Pediatric wide-field fundus photograph; 1240x1240; camera: Phoenix ICON (100° FOV) — 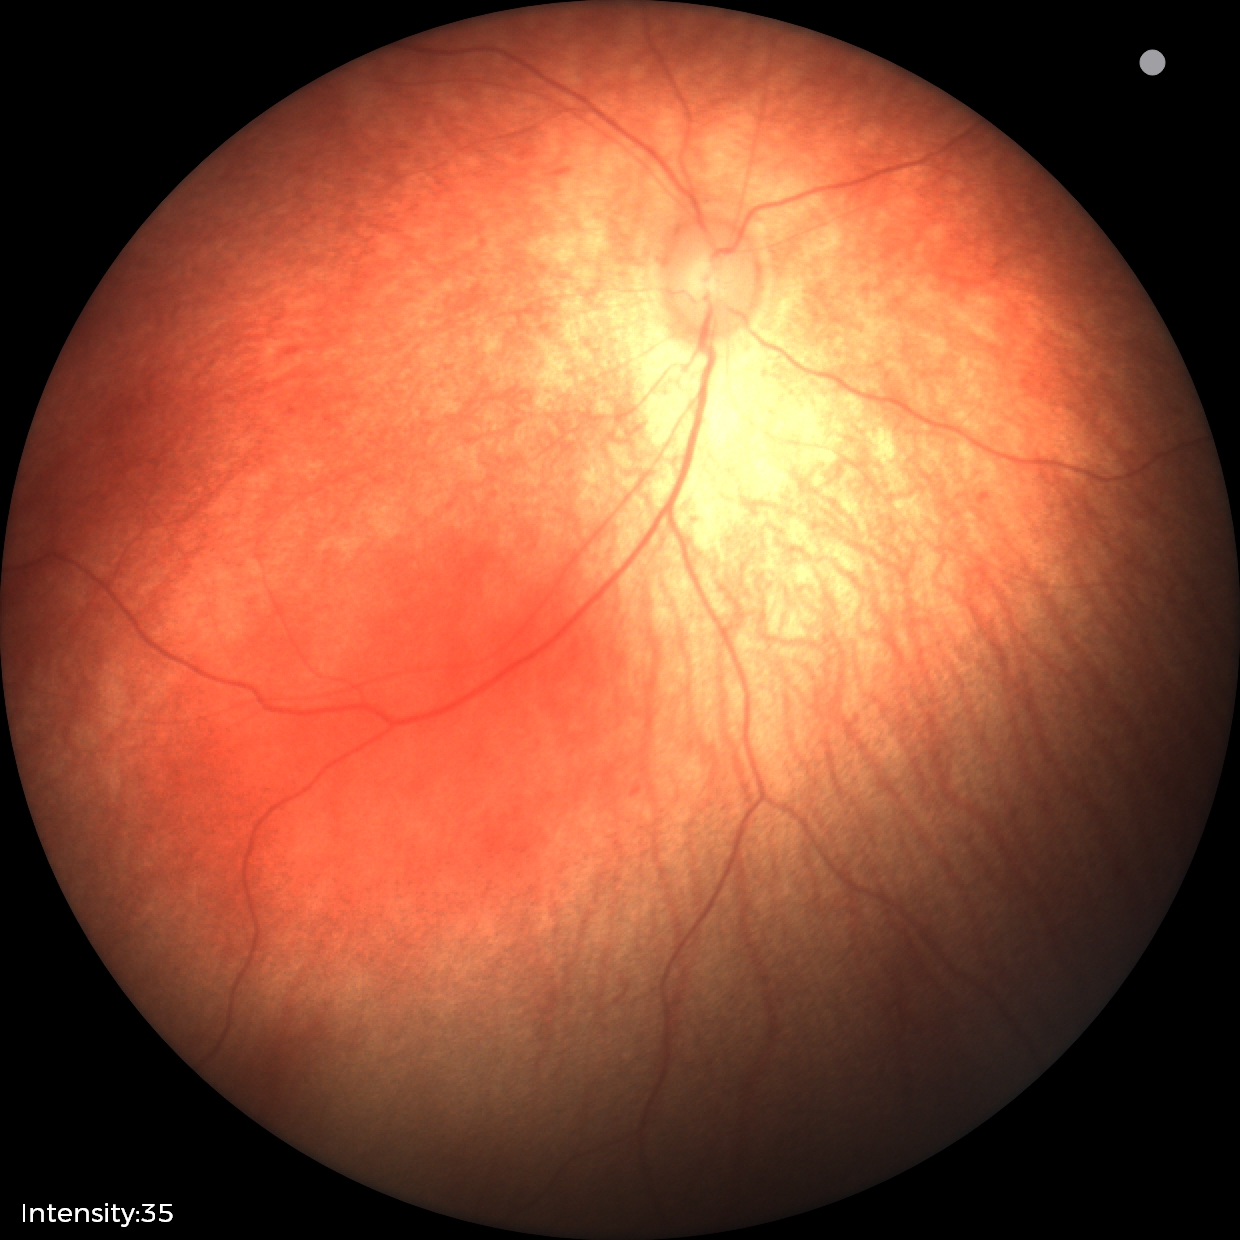 Examination with physiological retinal findings.